45° field of view. Color fundus photograph.
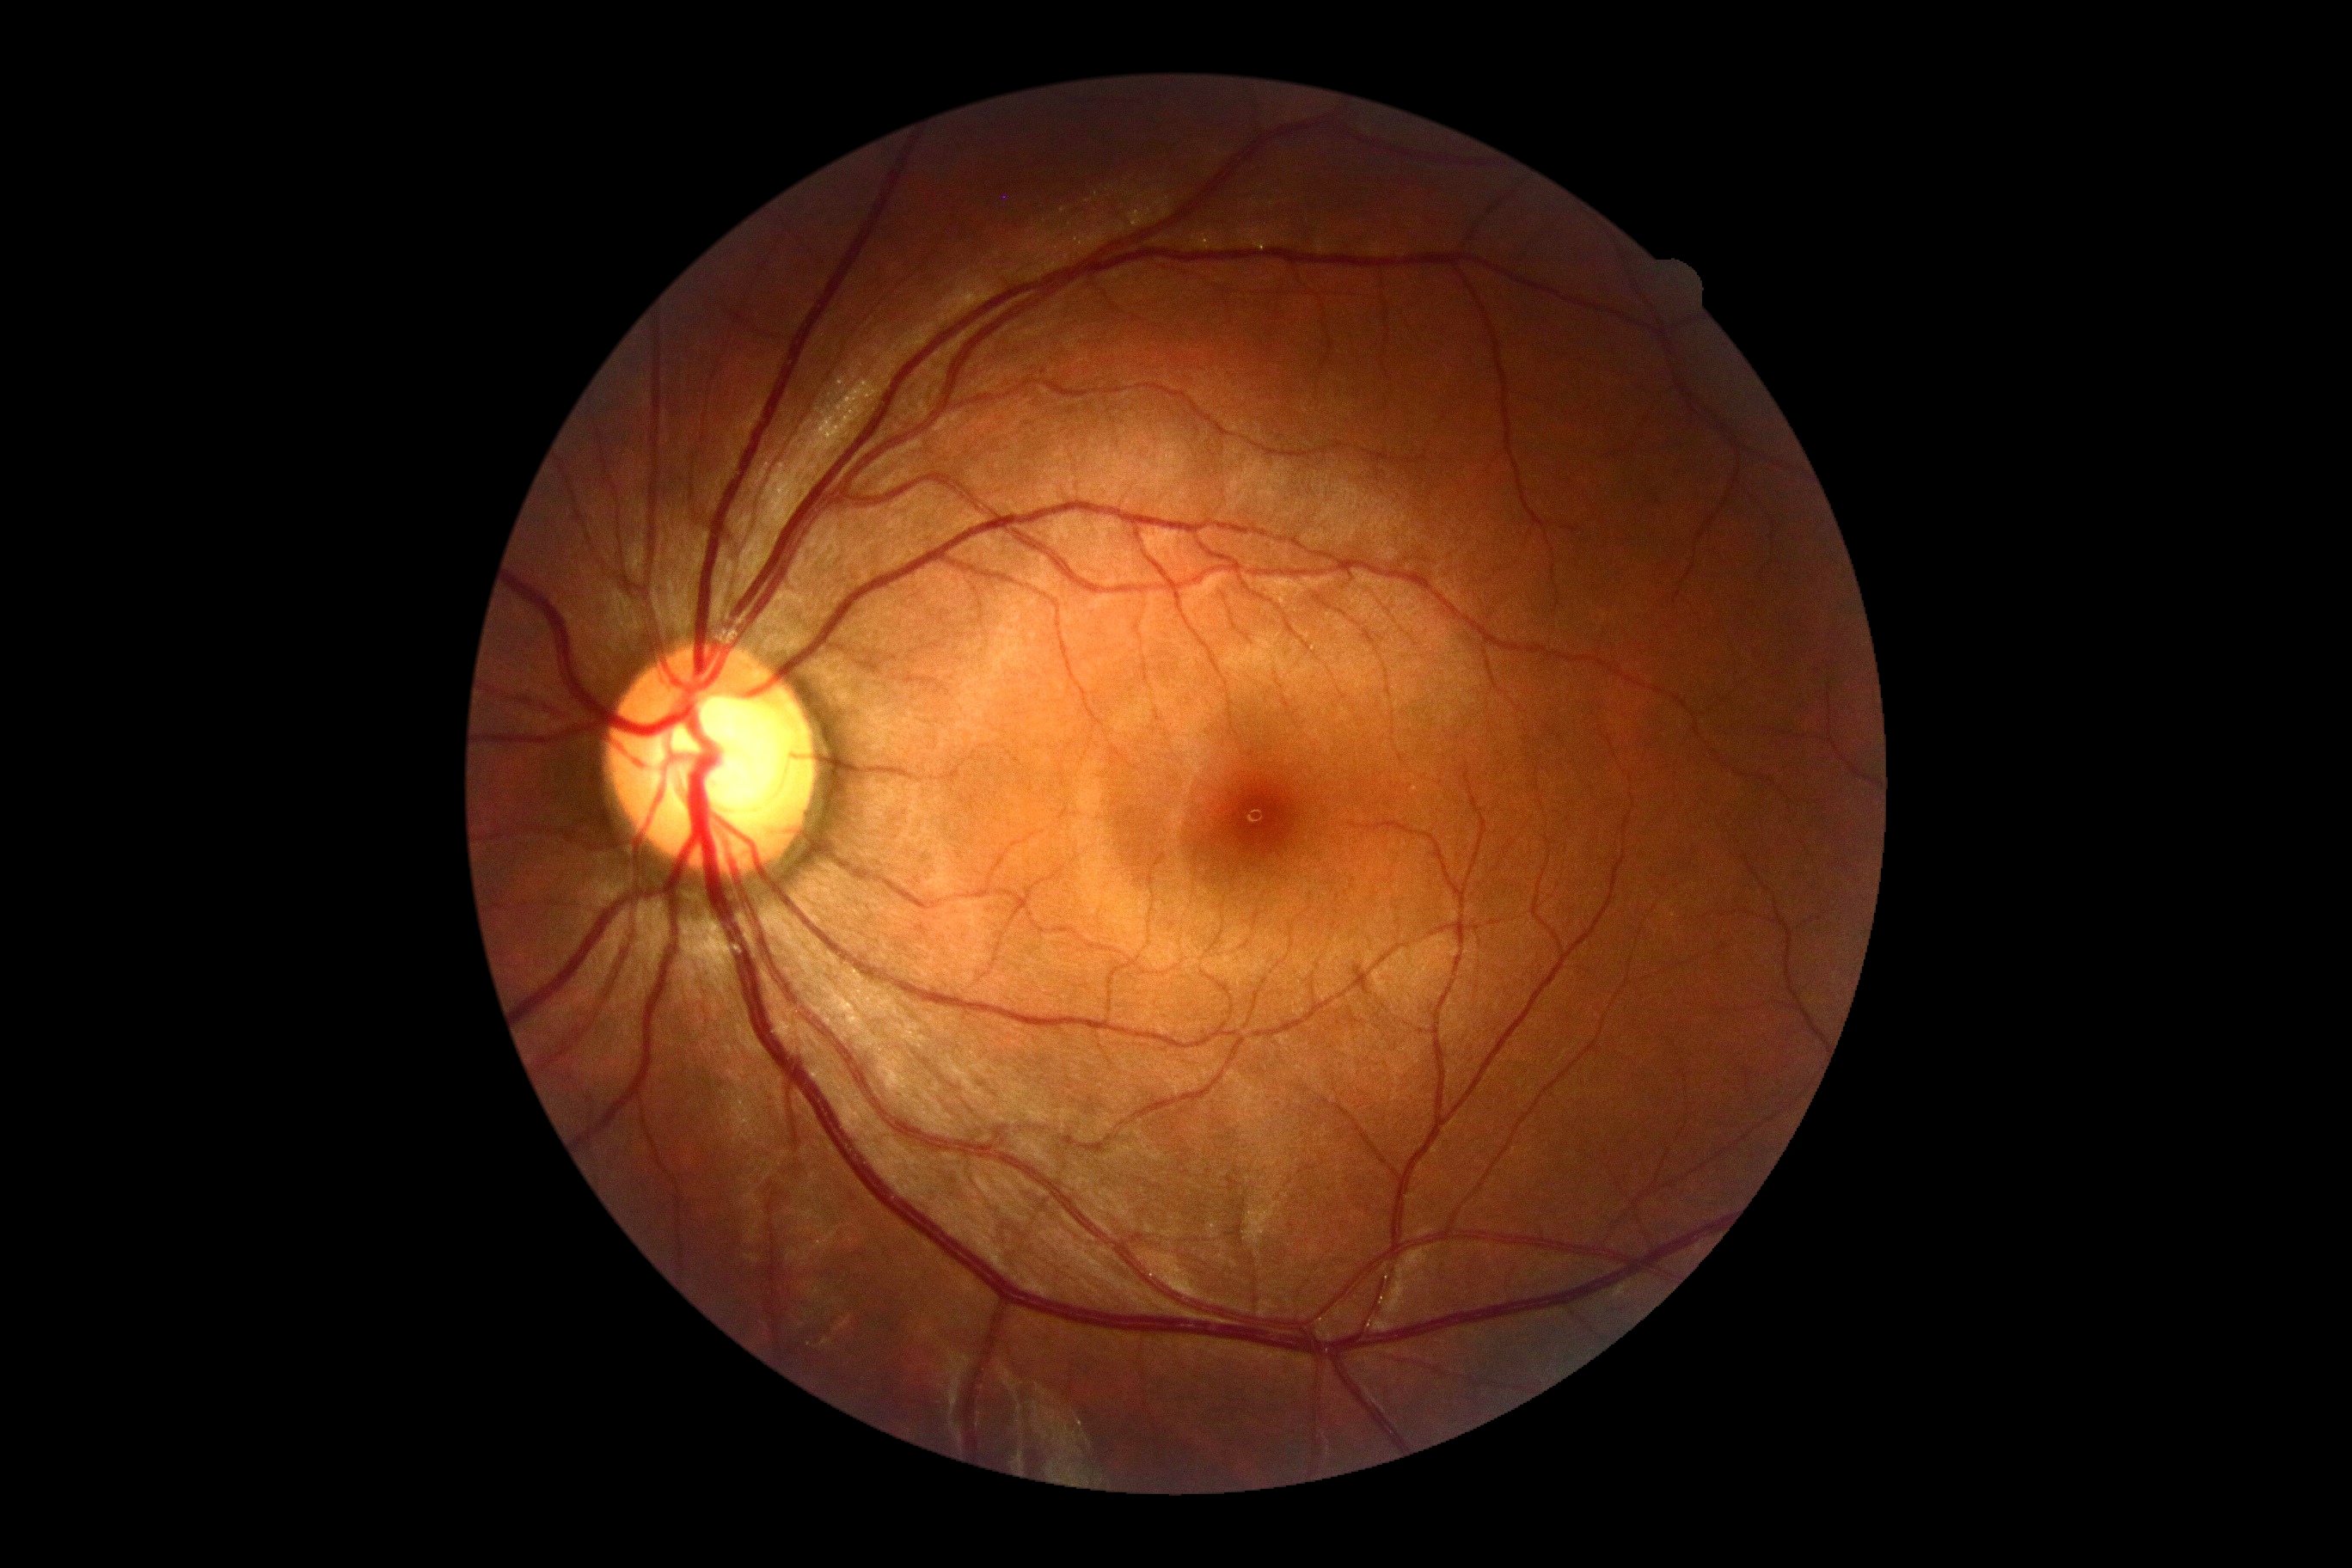

Diabetic retinopathy (DR): 0/4. No DR findings.